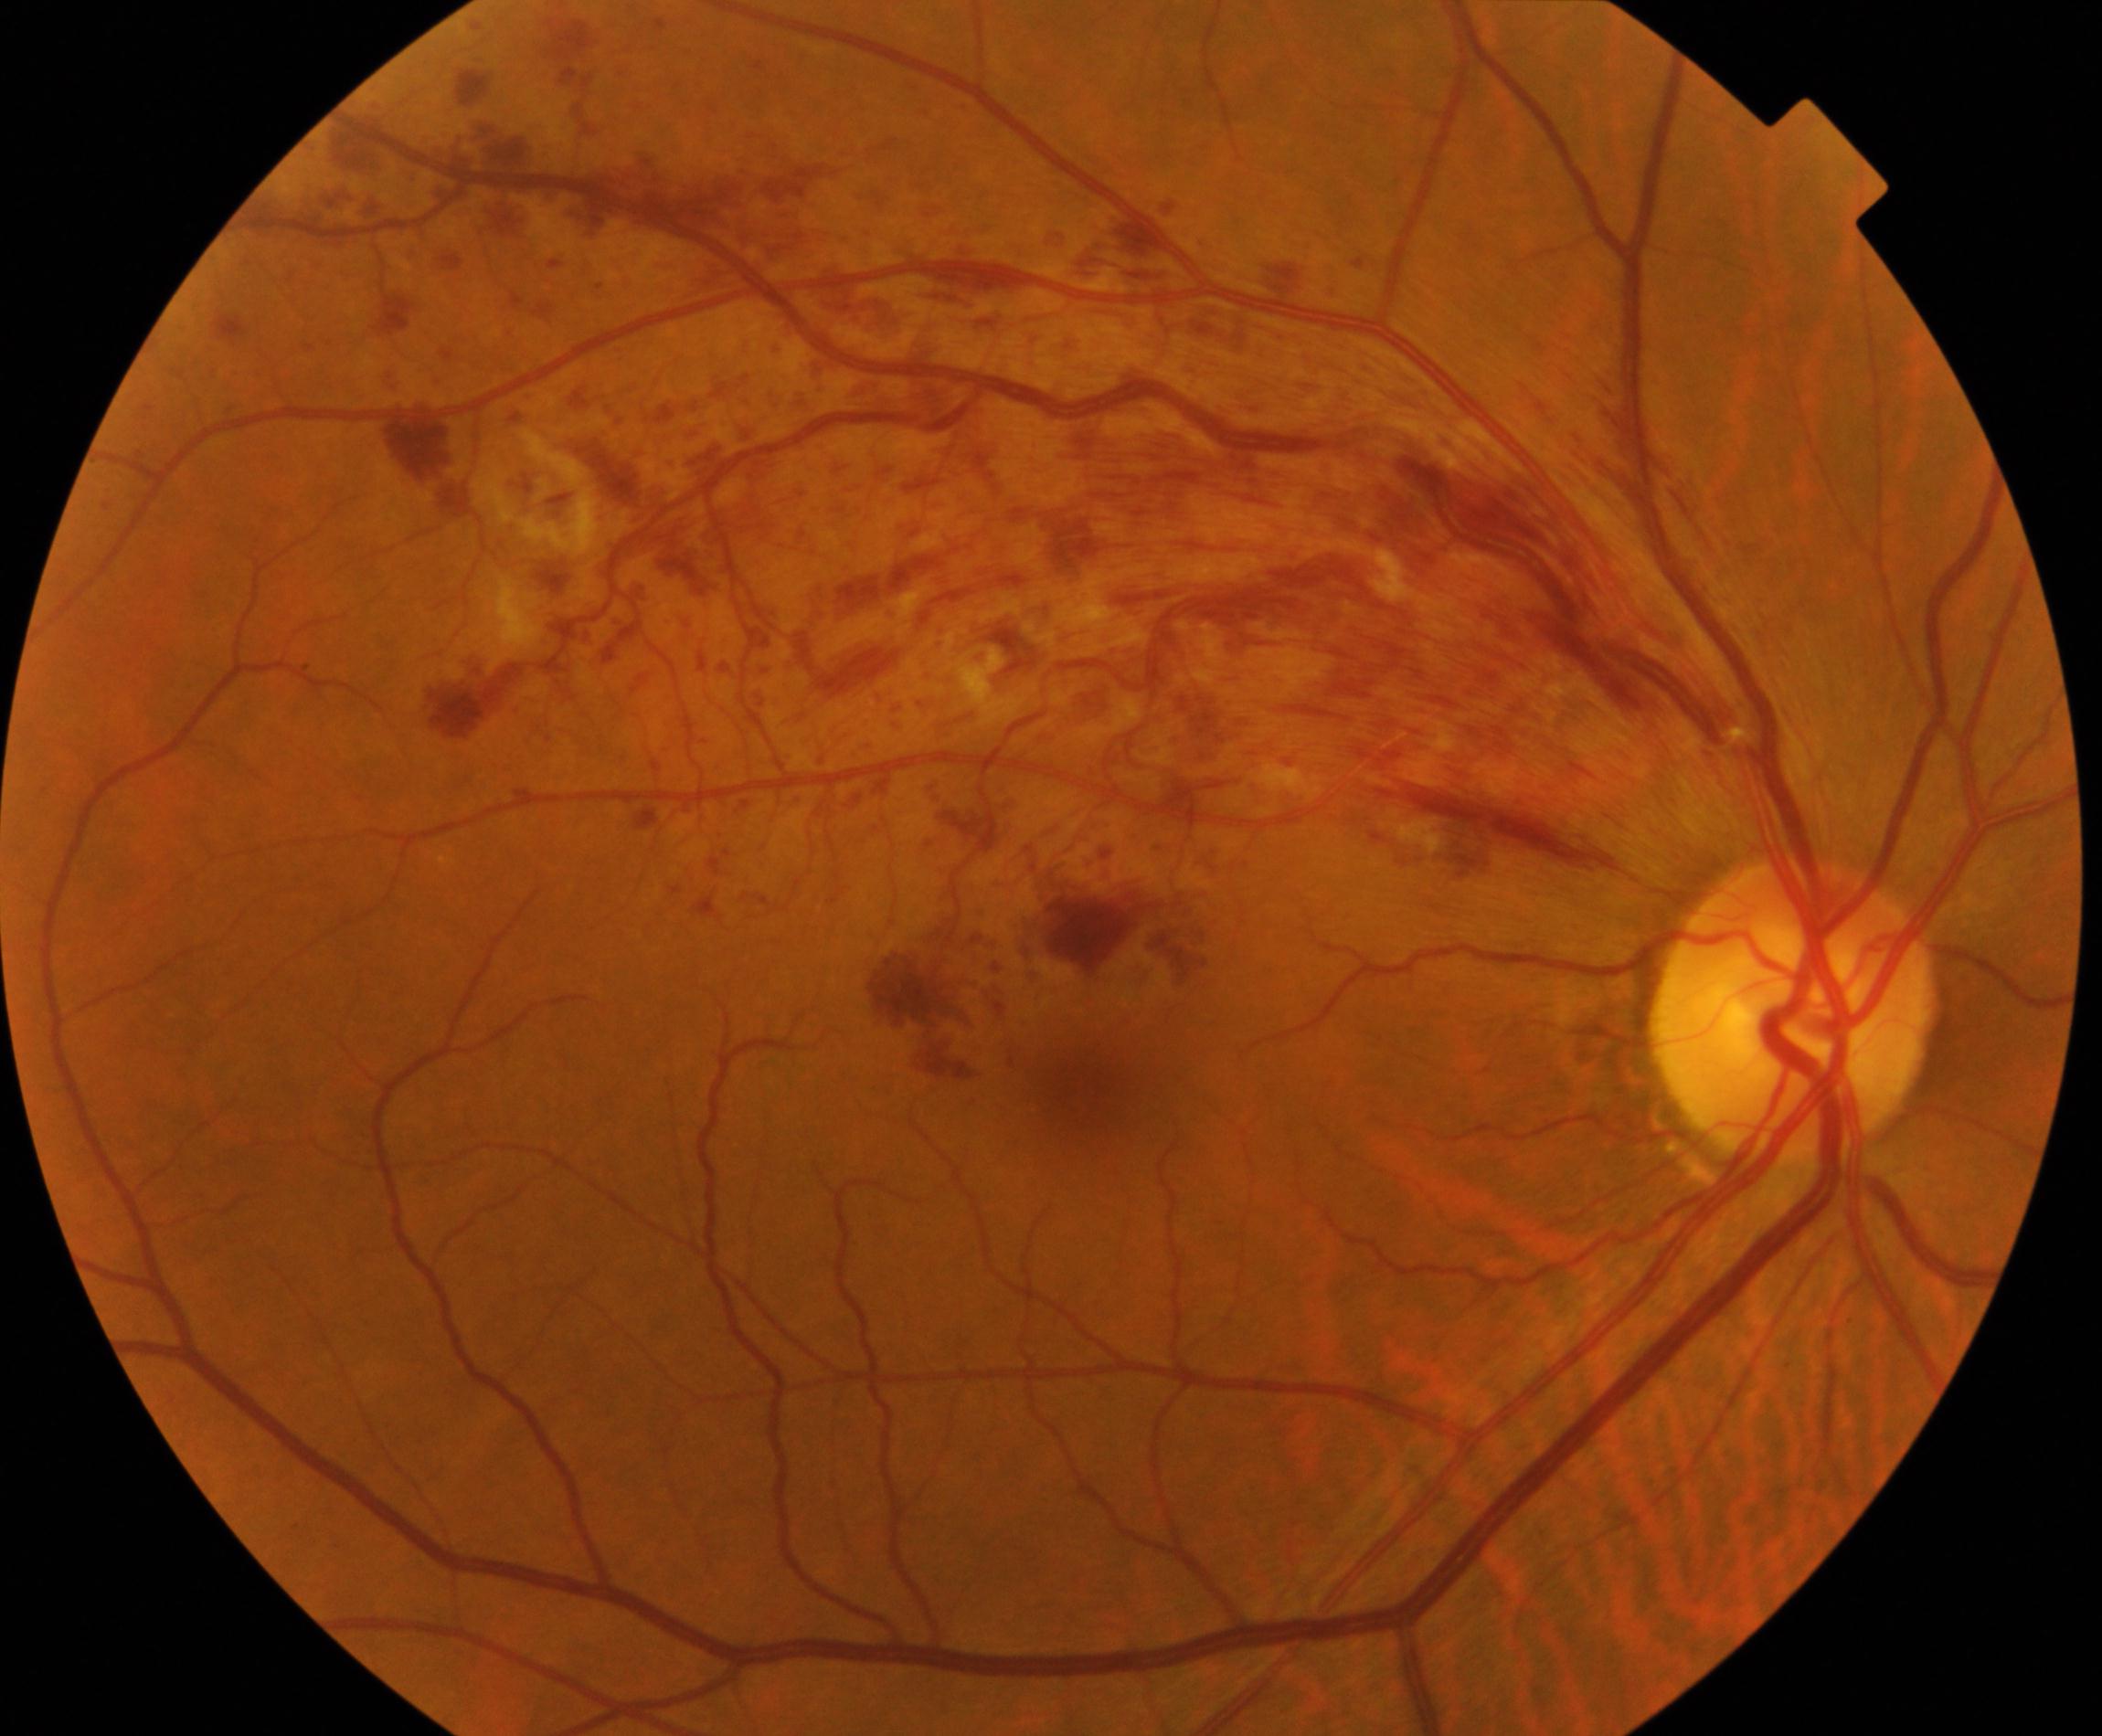 Classification: branch retinal vein occlusion (BRVO).